45° FOV. Color fundus image — 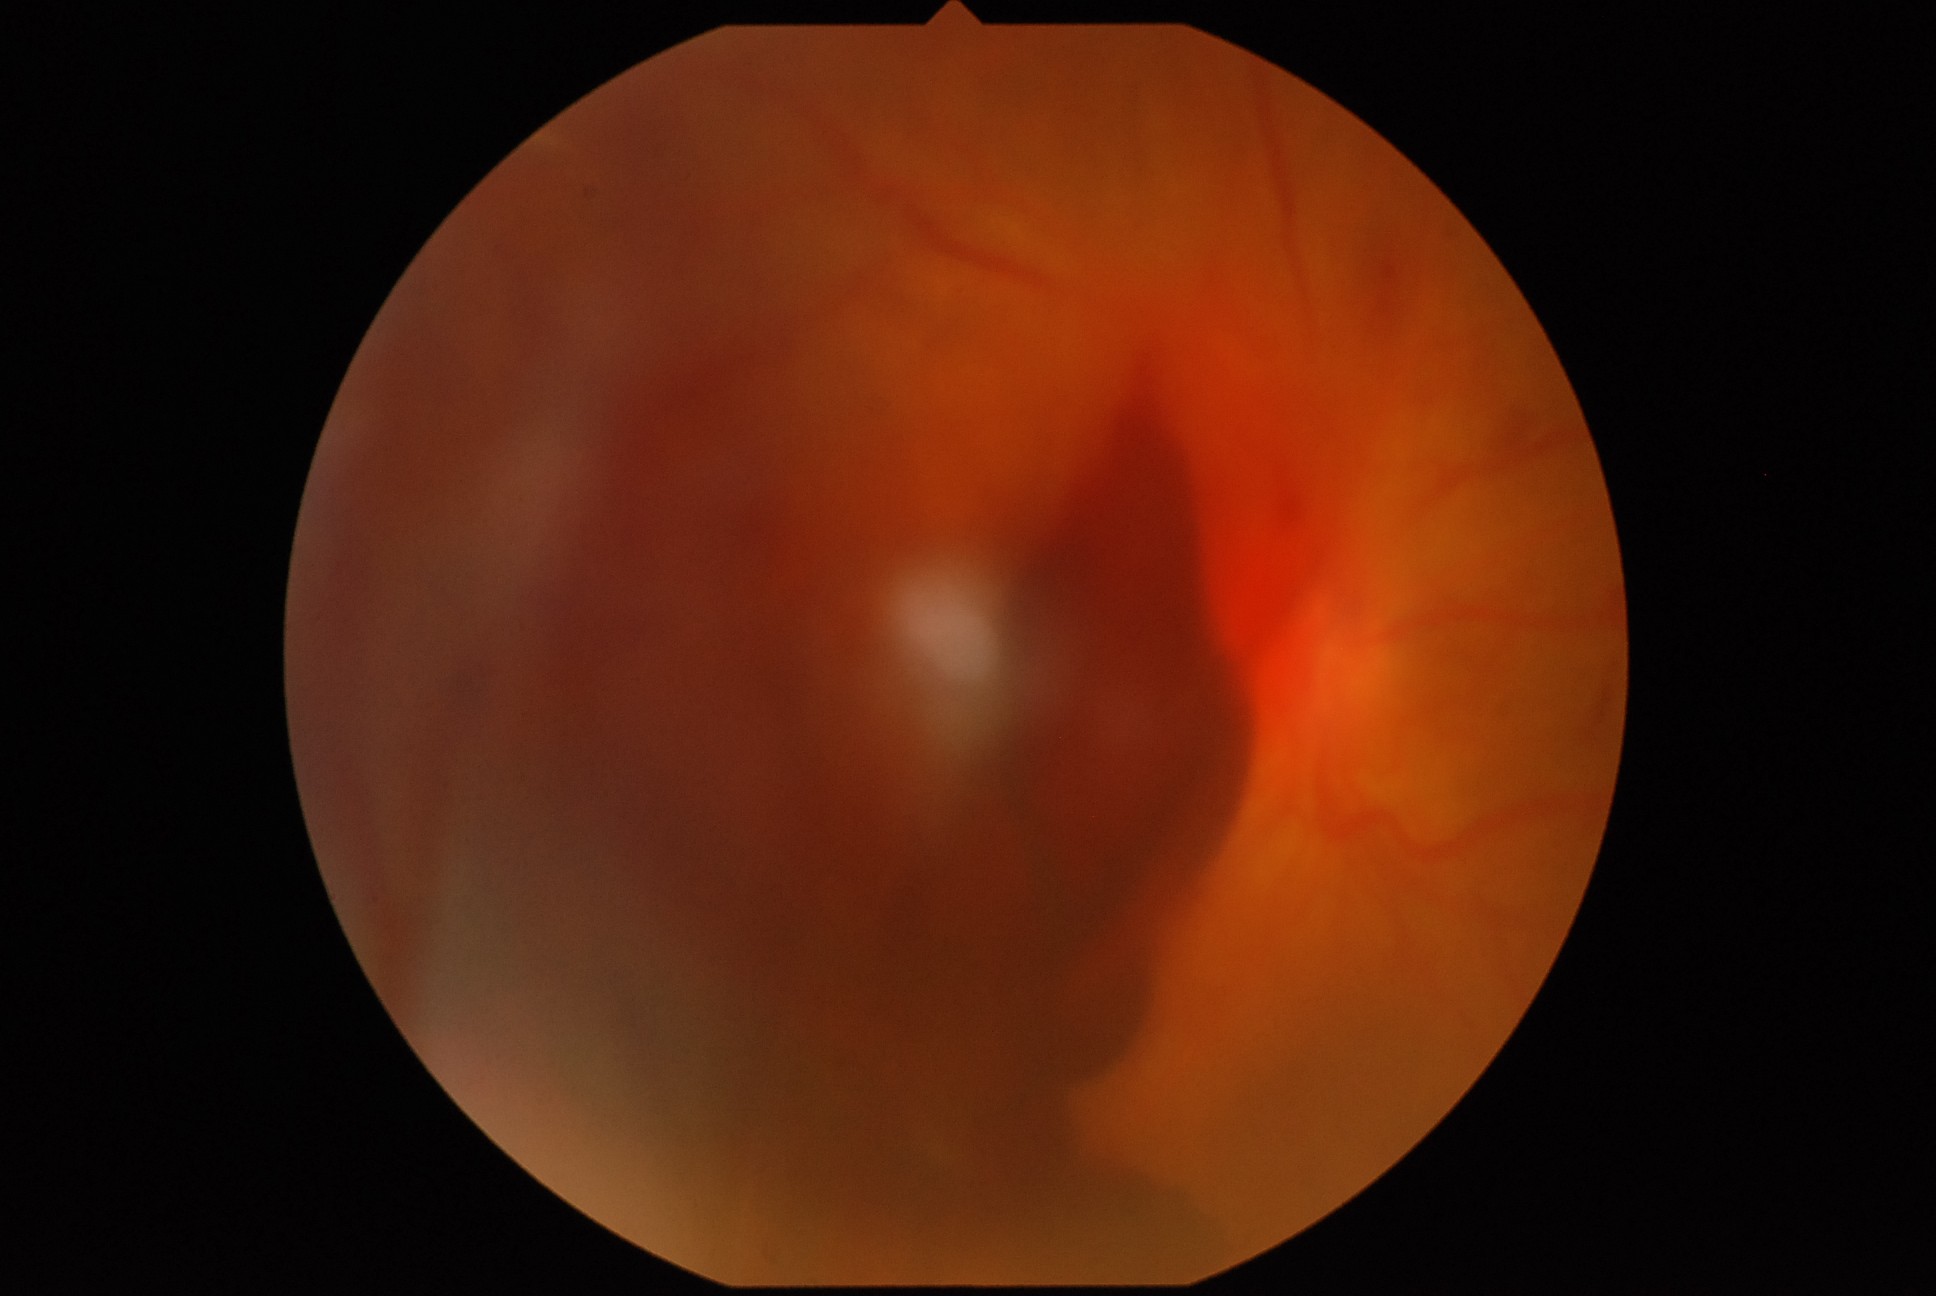 DR class: proliferative diabetic retinopathy. Retinopathy grade is PDR (4).